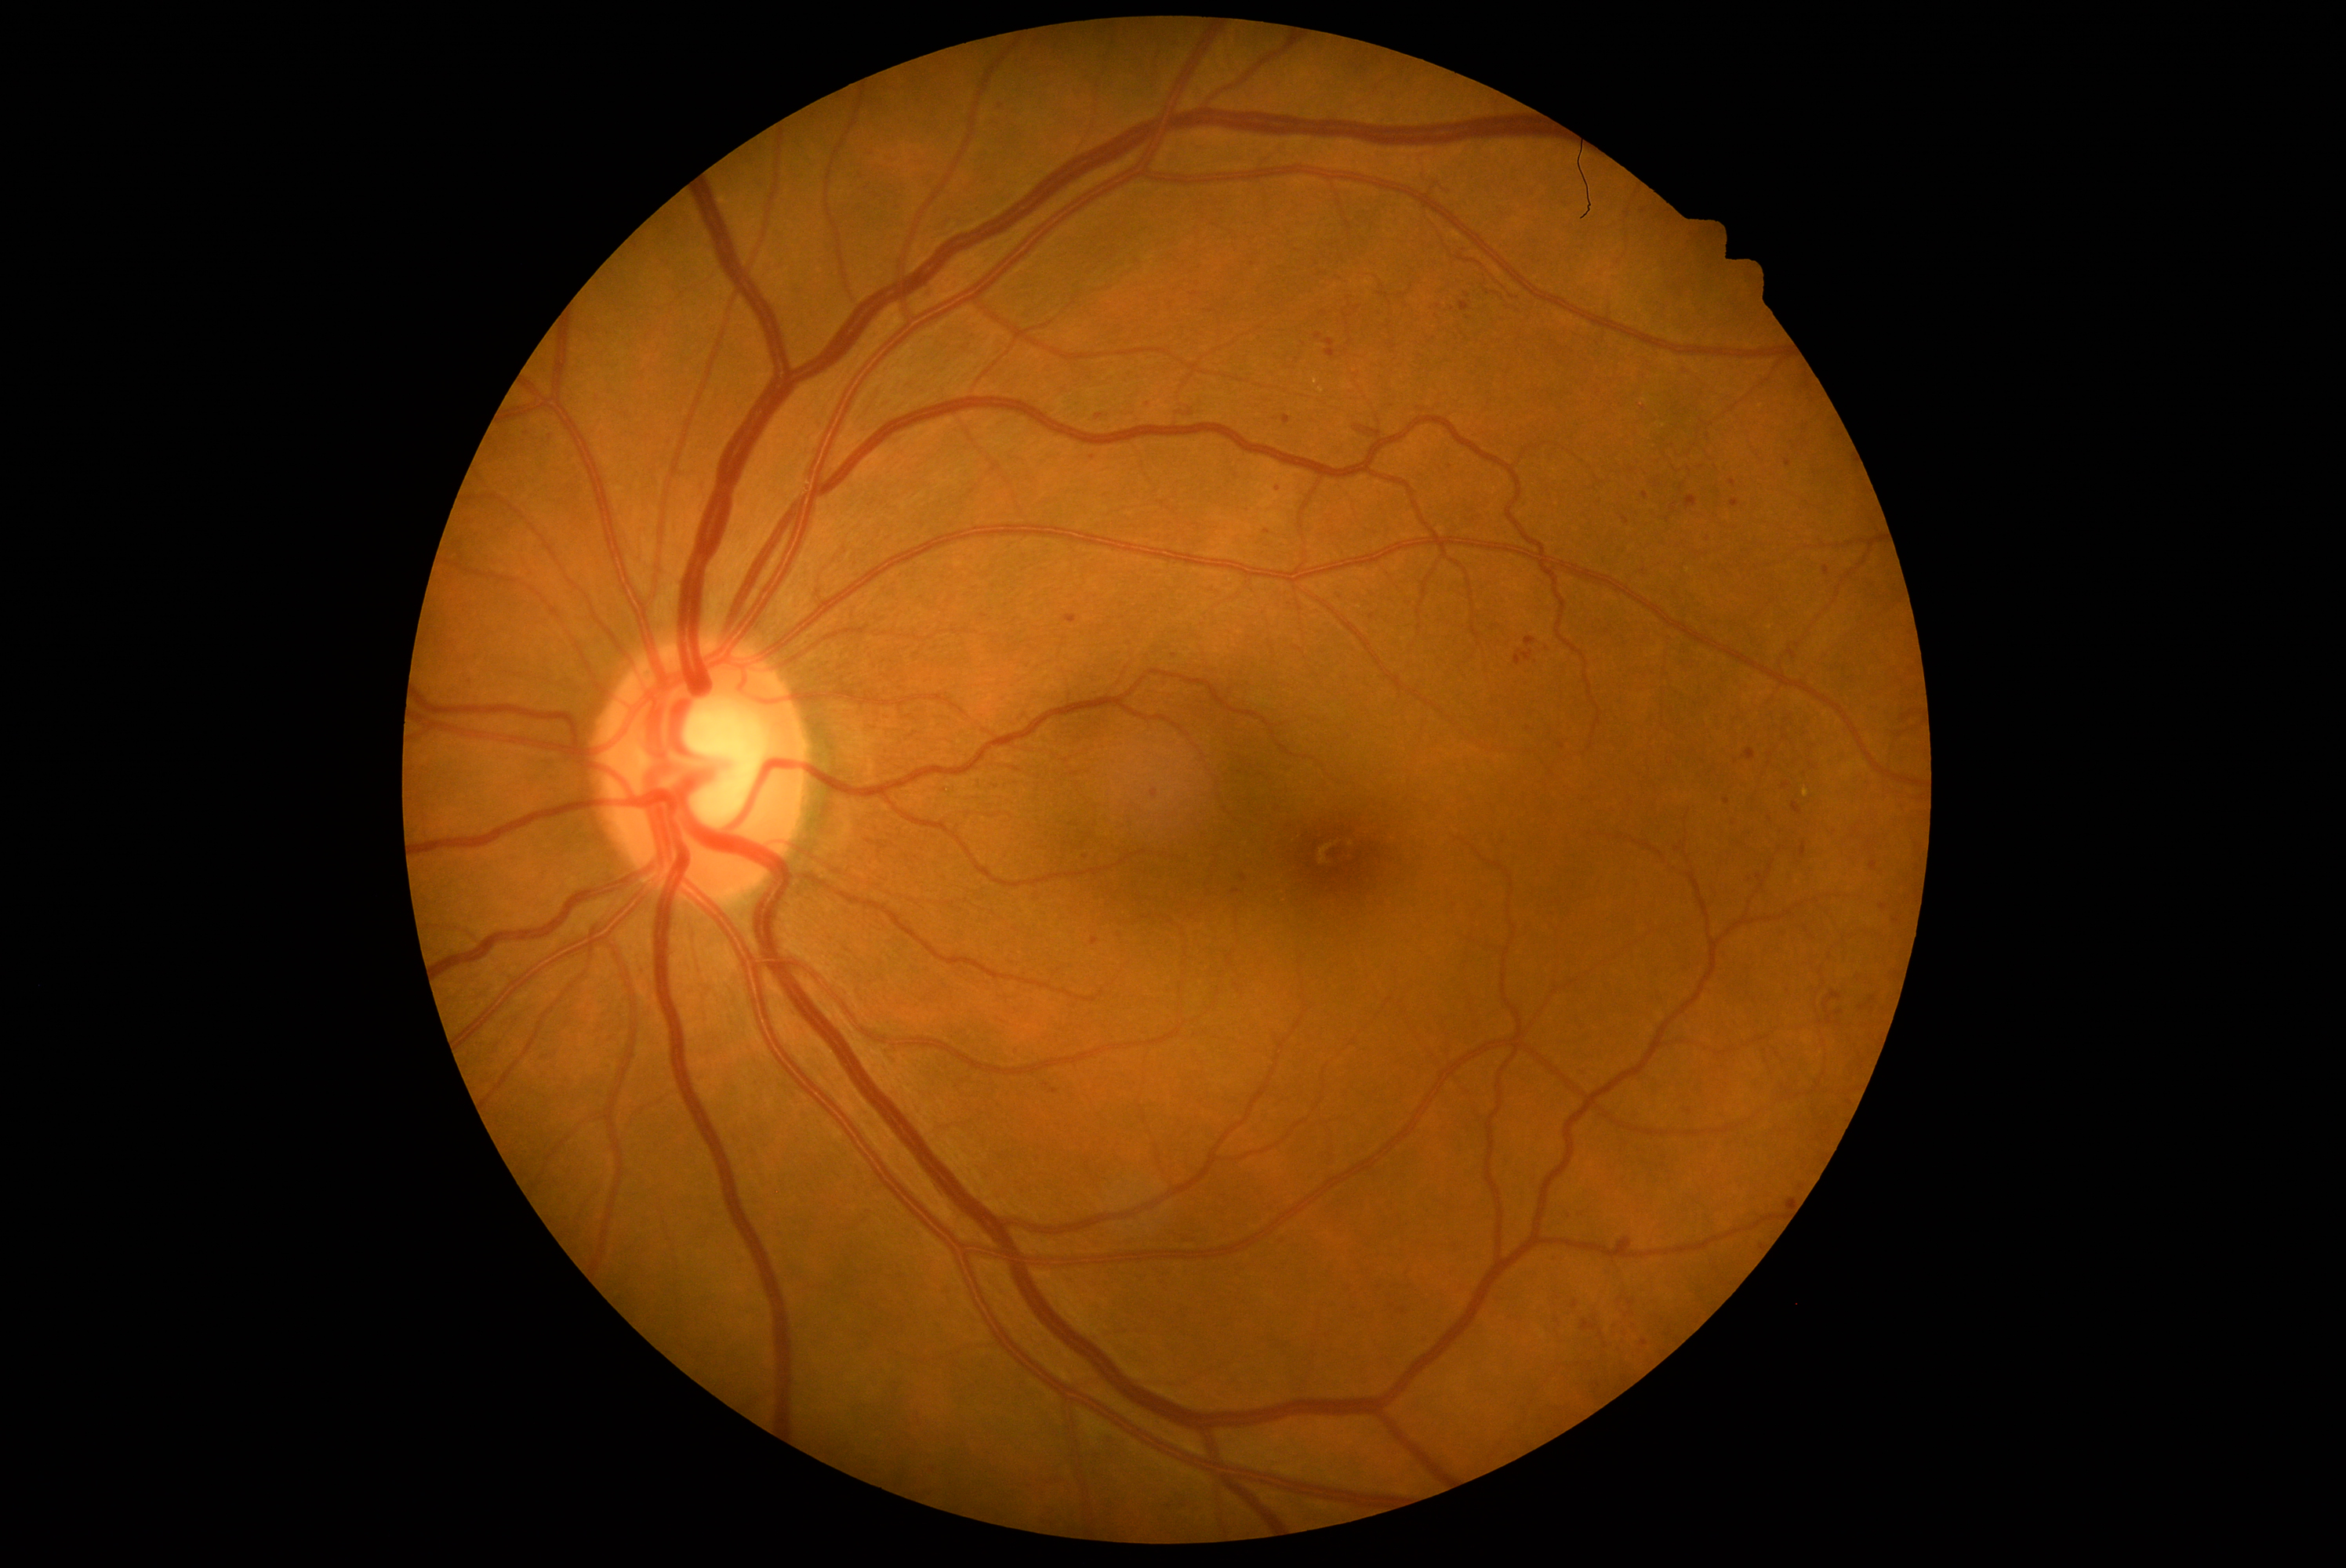
Diabetic retinopathy (DR) is grade 2
A subset of detected lesions:
microaneurysms (MAs) (partial) = (x1=1756, y1=876, x2=1763, y2=890); (x1=1514, y1=650, x2=1533, y2=666); (x1=1274, y1=1236, x2=1287, y2=1244); (x1=520, y1=429, x2=532, y2=440); (x1=1315, y1=333, x2=1323, y2=339); (x1=677, y1=212, x2=694, y2=225); (x1=1191, y1=292, x2=1200, y2=296); (x1=1375, y1=307, x2=1382, y2=316); (x1=1743, y1=990, x2=1756, y2=1001); (x1=1619, y1=1329, x2=1627, y2=1337); (x1=1629, y1=879, x2=1643, y2=891); (x1=1629, y1=1109, x2=1640, y2=1120)
Small MAs near {"x": 1798, "y": 646}; {"x": 1575, "y": 1305}; {"x": 1393, "y": 1305}; {"x": 1558, "y": 1321}; {"x": 1644, "y": 571}; {"x": 1749, "y": 277}; {"x": 1493, "y": 628}